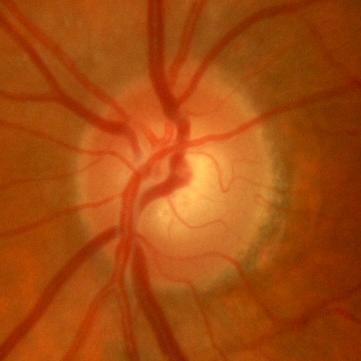
Optic nerve head appearance consistent with no glaucoma.